Fundus photo taken with a portable handheld camera:
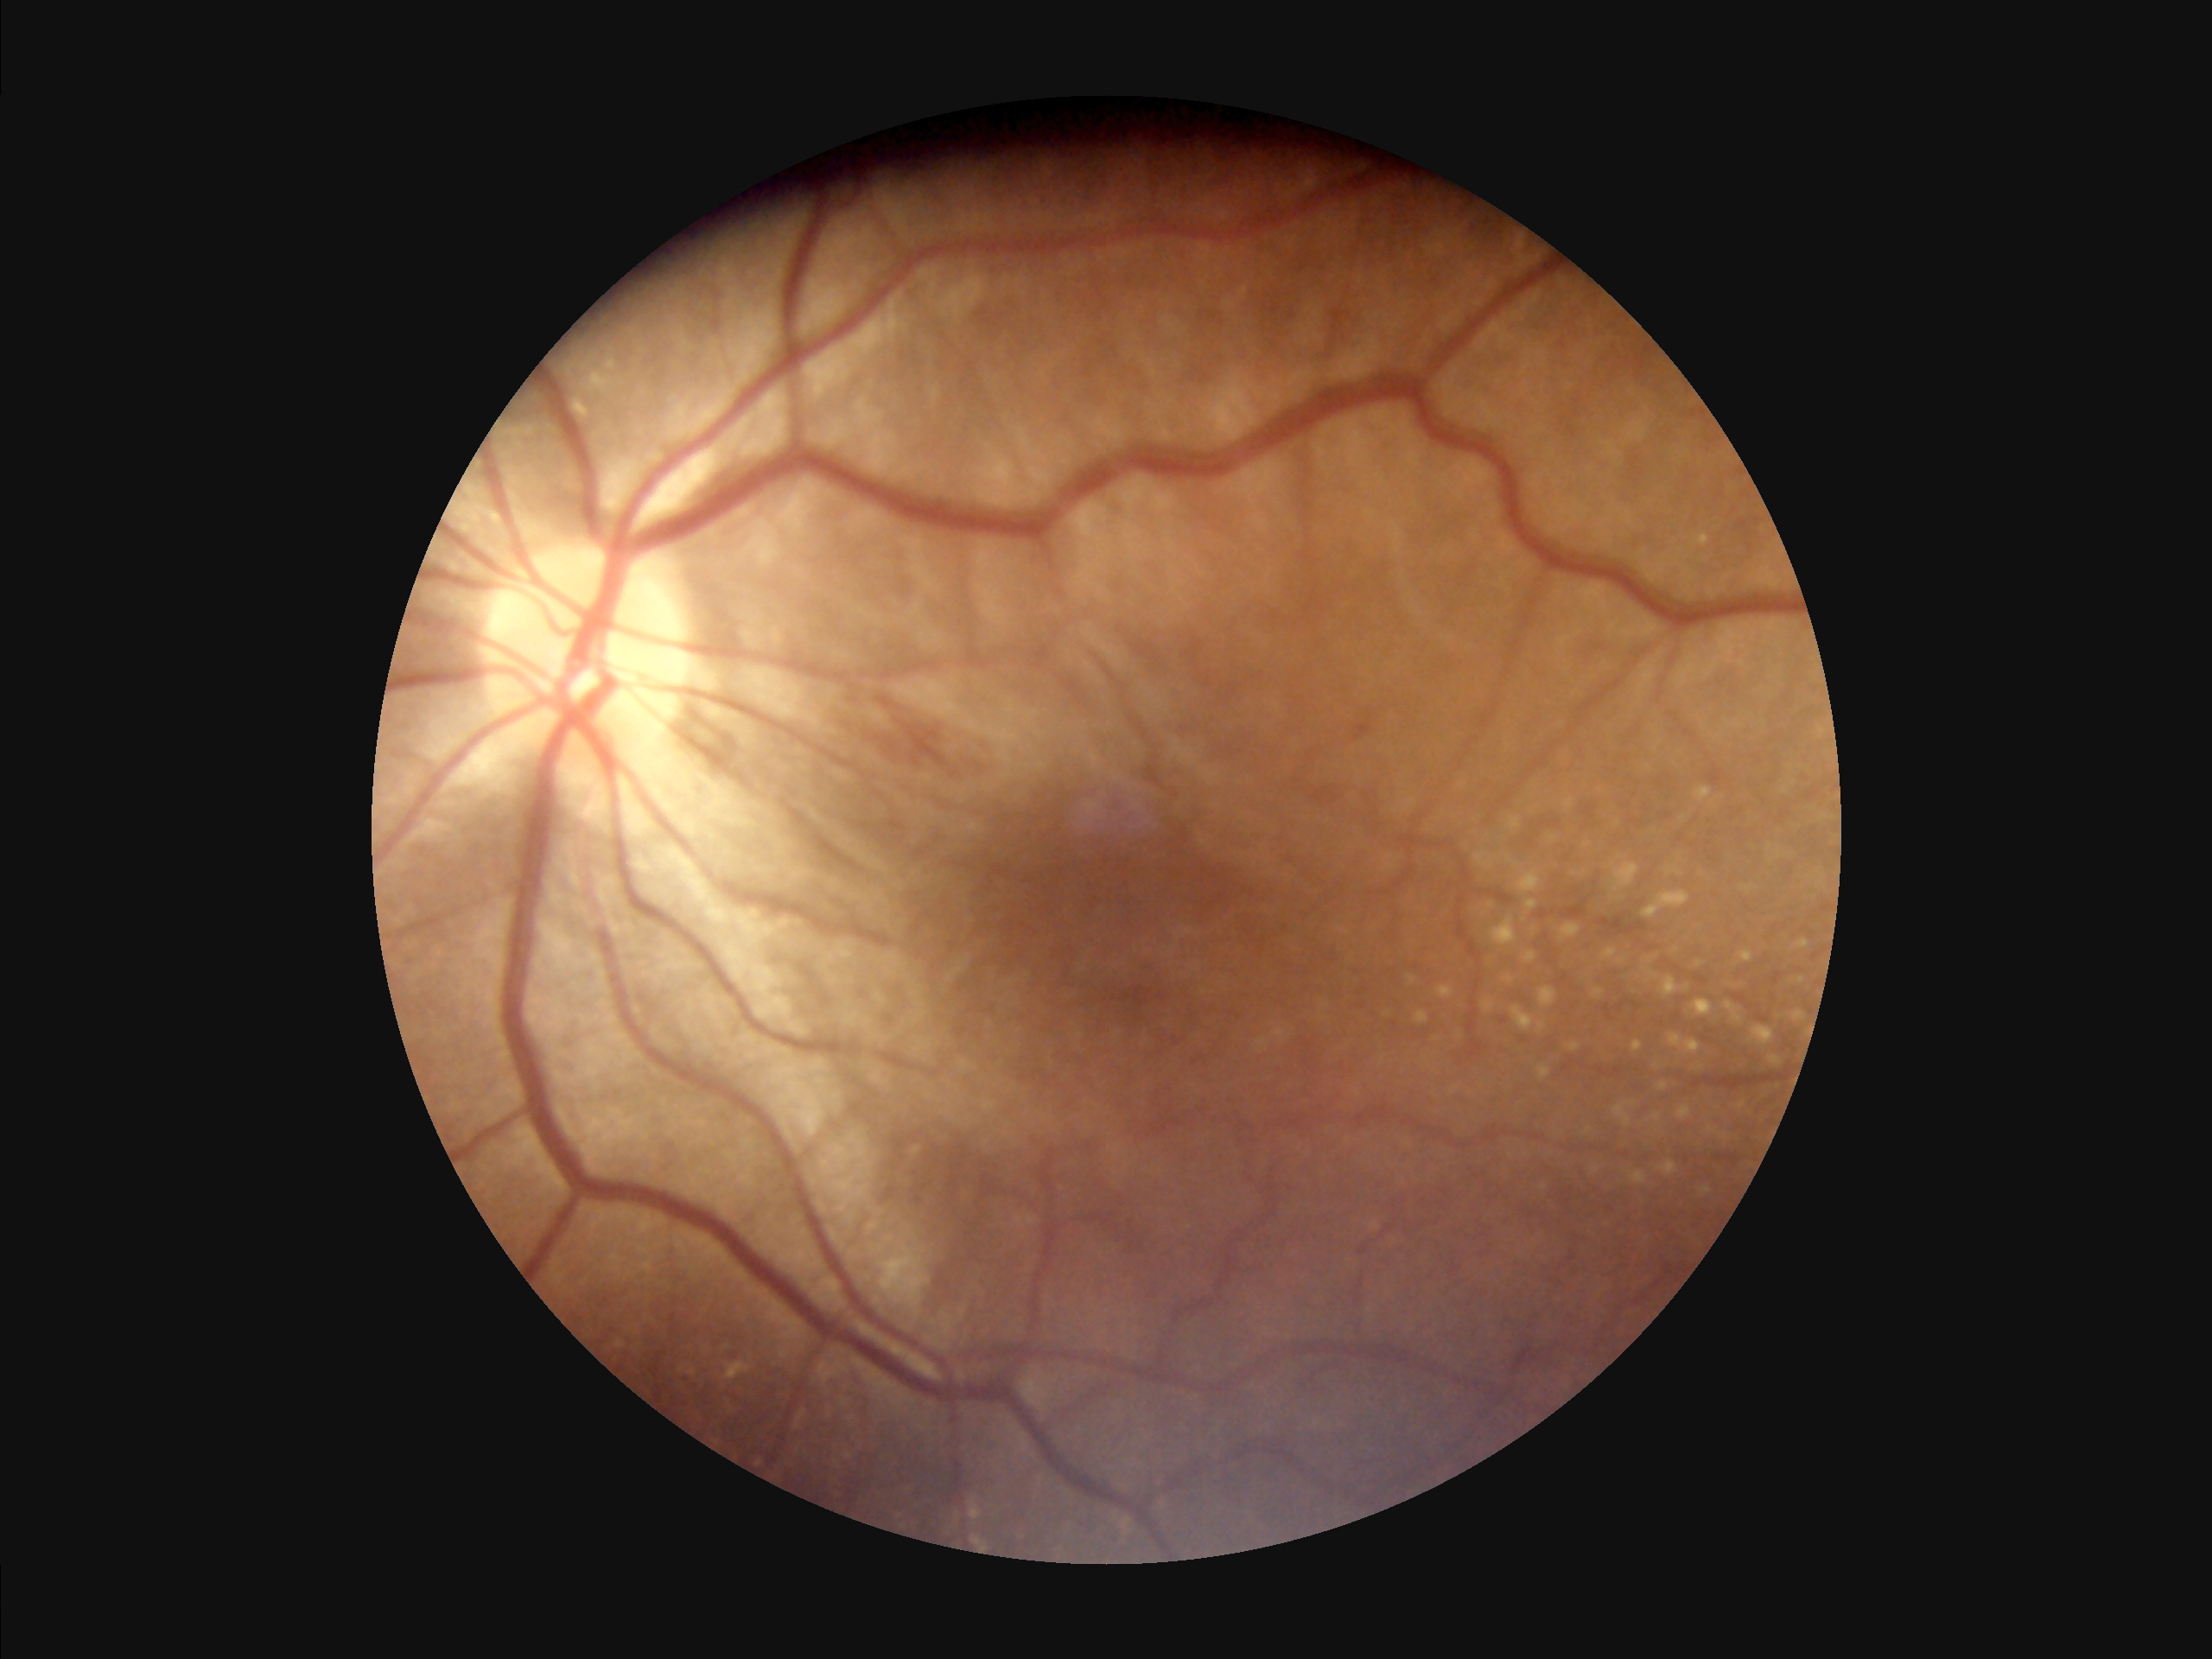

Quality grading:
- illumination/color: good
- contrast: satisfactory
- sharpness: sharp